Infant wide-field fundus photograph
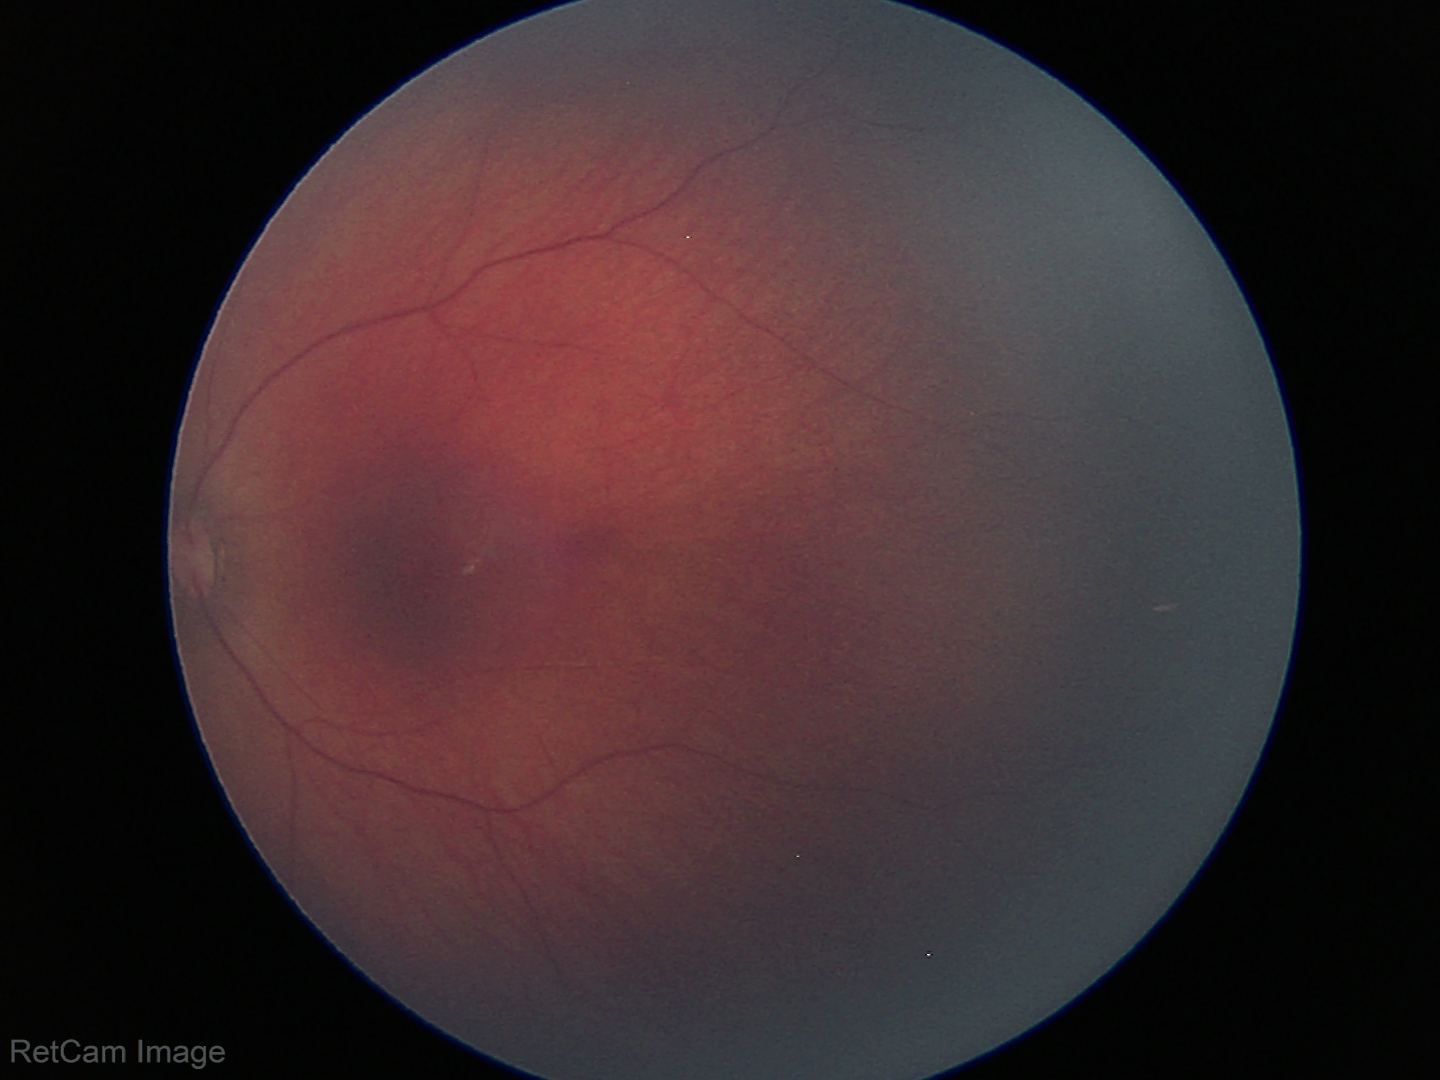

Screening examination with no abnormal retinal findings.